Portable fundus photograph, 60° FOV, 2212 by 1659 pixels
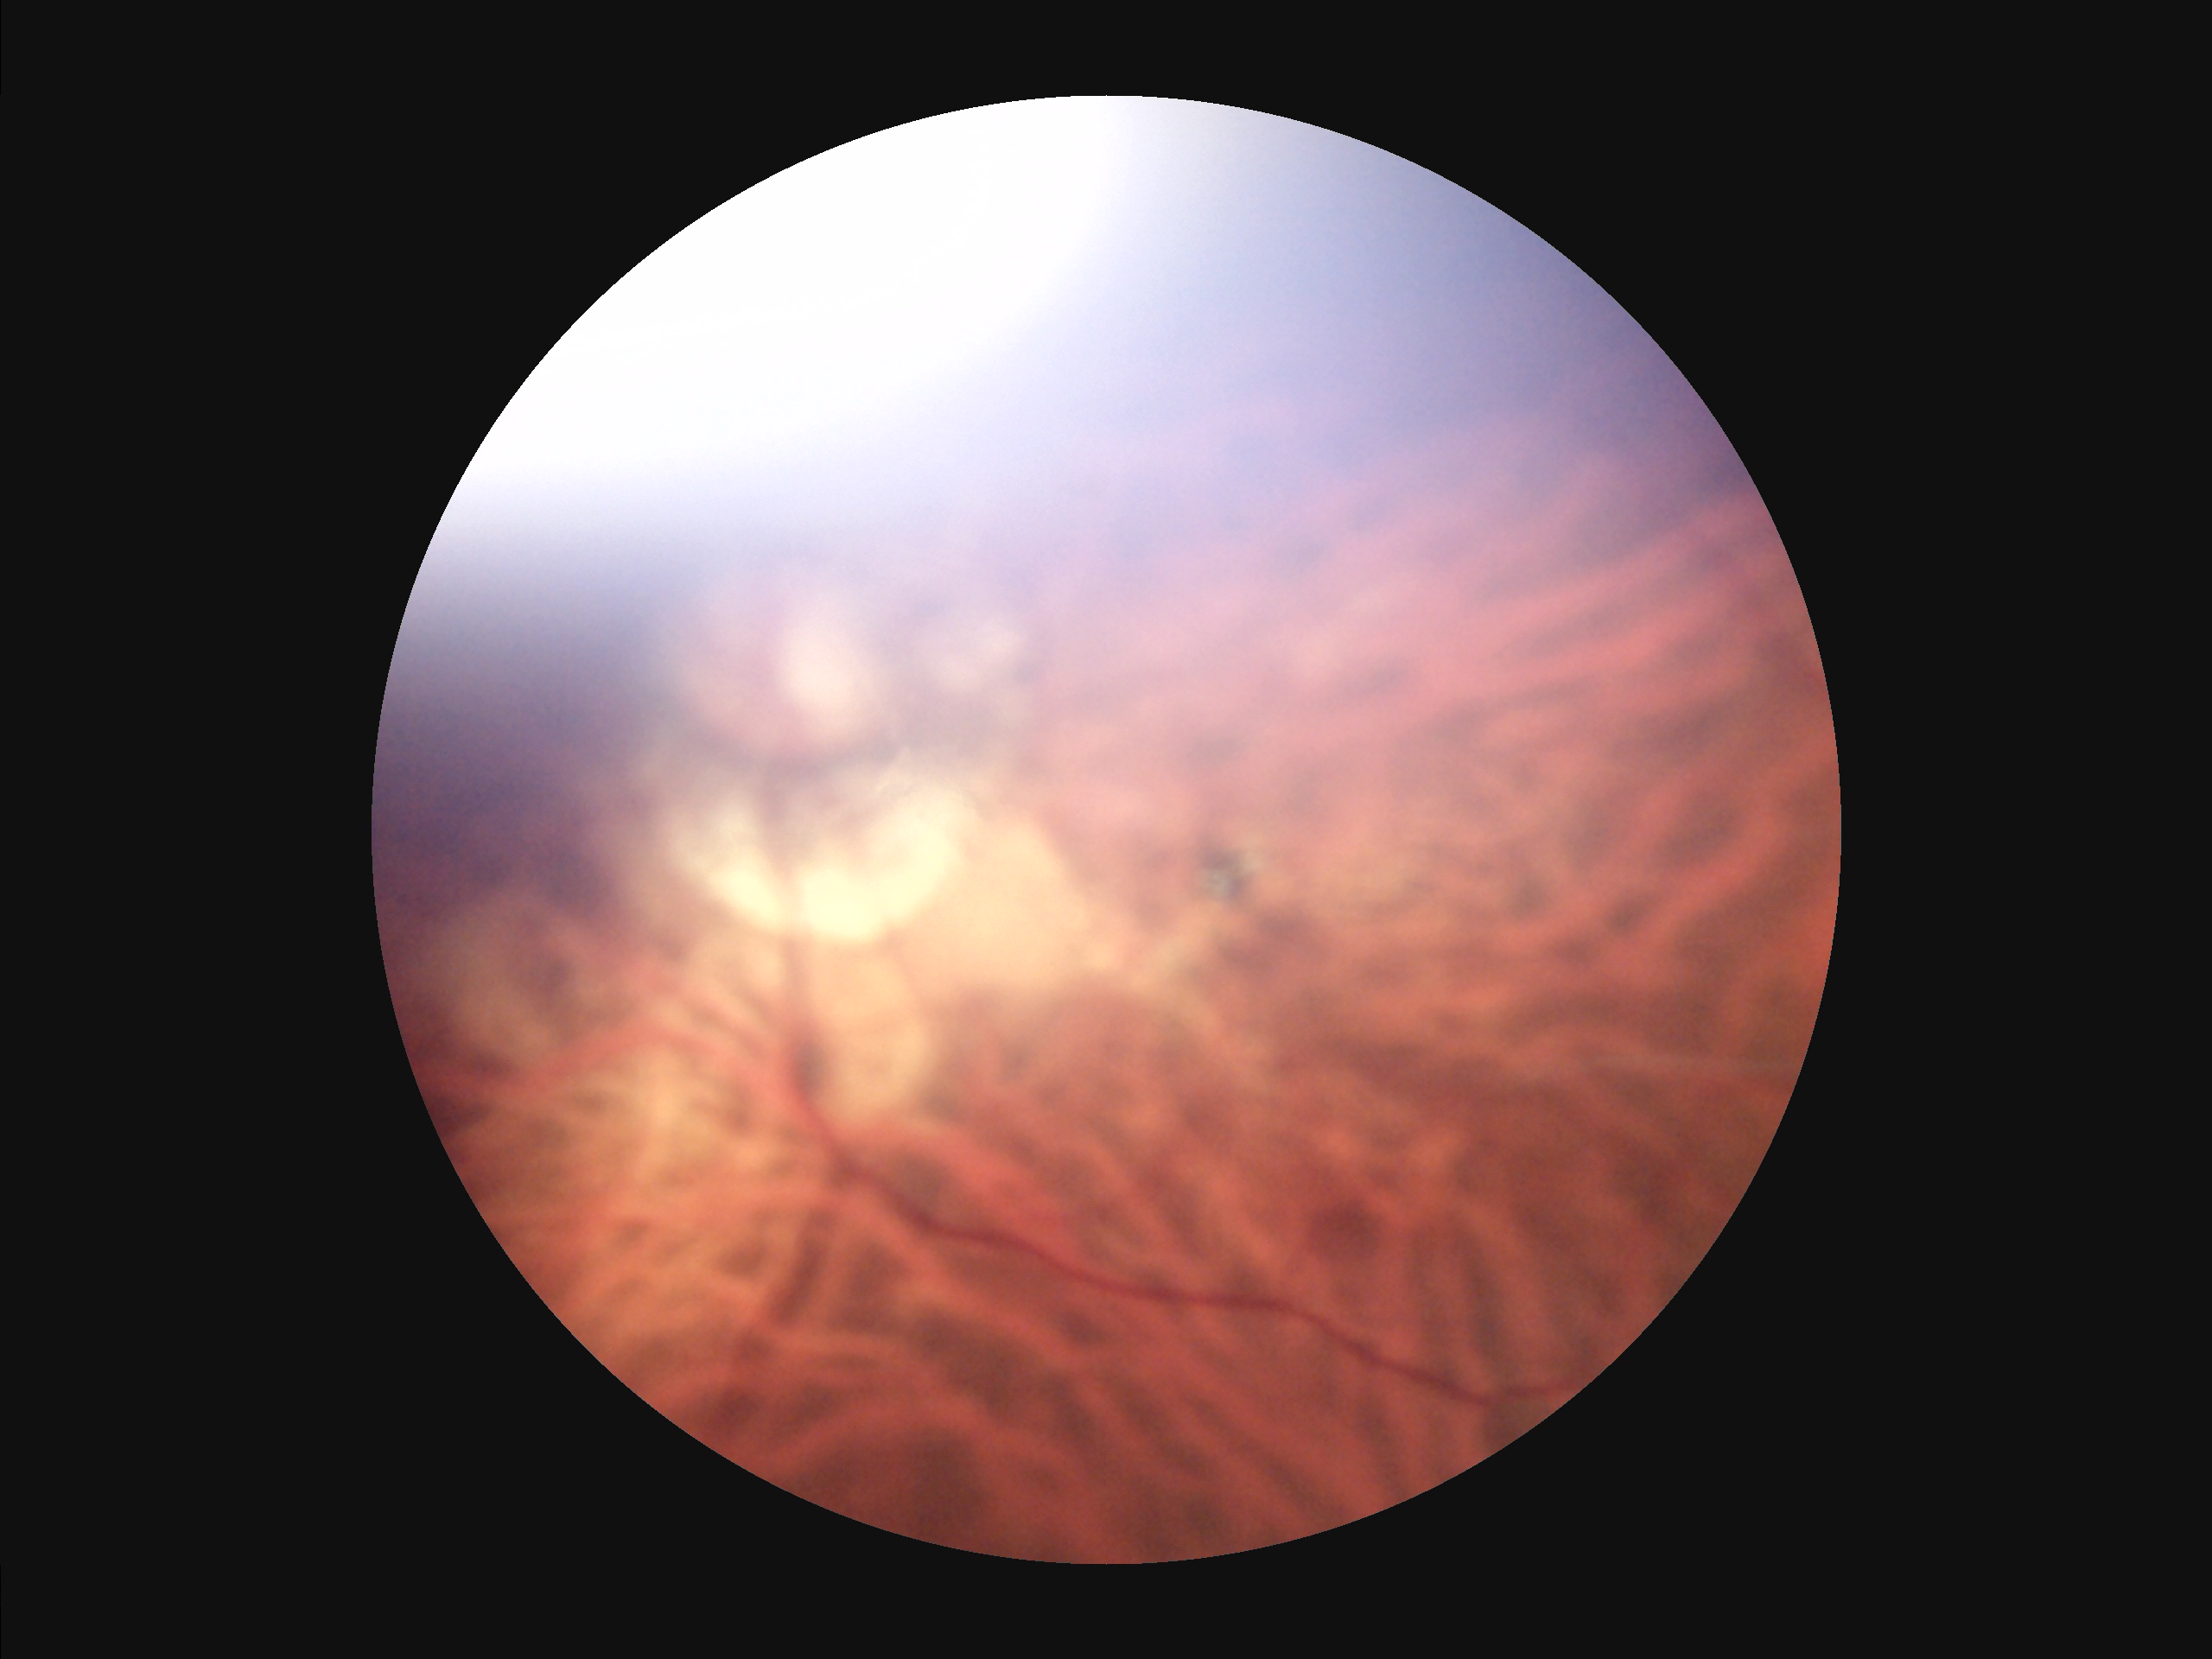

Image quality assessment:
- overall: inadequate for clinical interpretation
- contrast: good dynamic range
- focus: out of focus, structures indistinct
- illumination/color: inadequate, with uneven exposure or color distortion